Graded on the modified Davis scale:
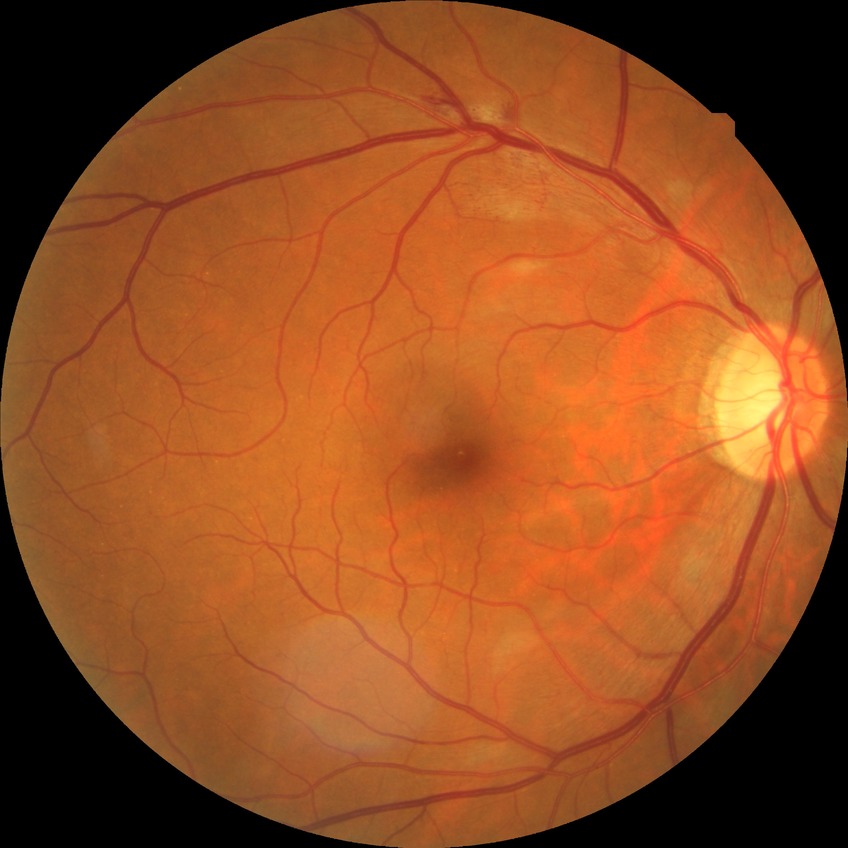

Diabetic retinopathy (DR): PPDR (pre-proliferative diabetic retinopathy).